Davis DR grading
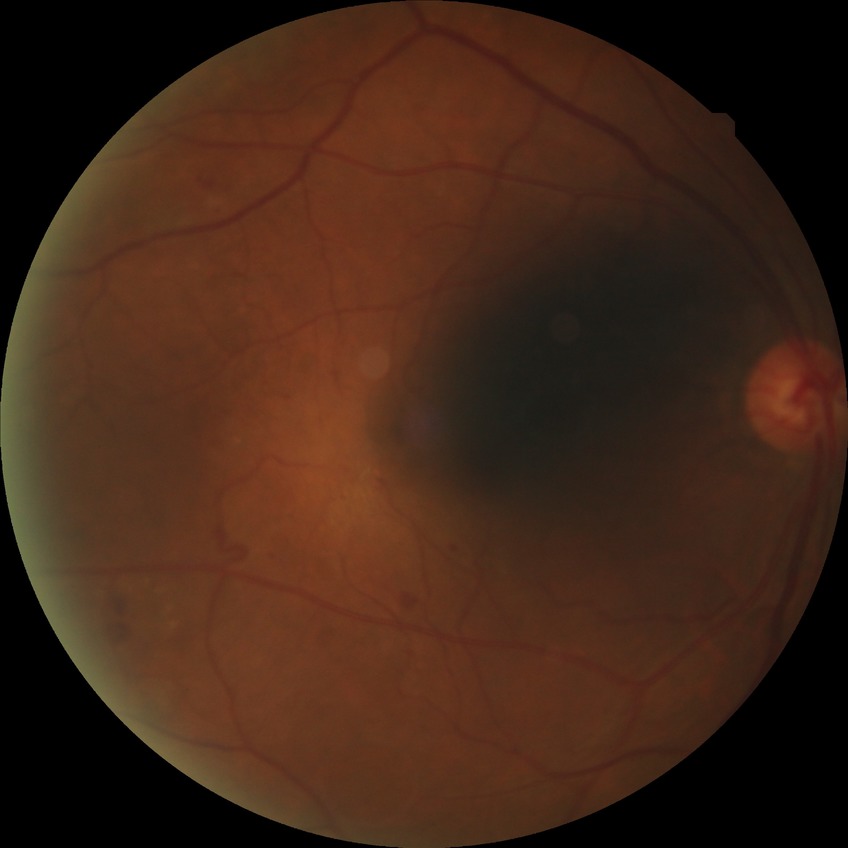
diabetic retinopathy (DR): proliferative diabetic retinopathy (PDR)